Diabetic retinopathy graded by the modified Davis classification.
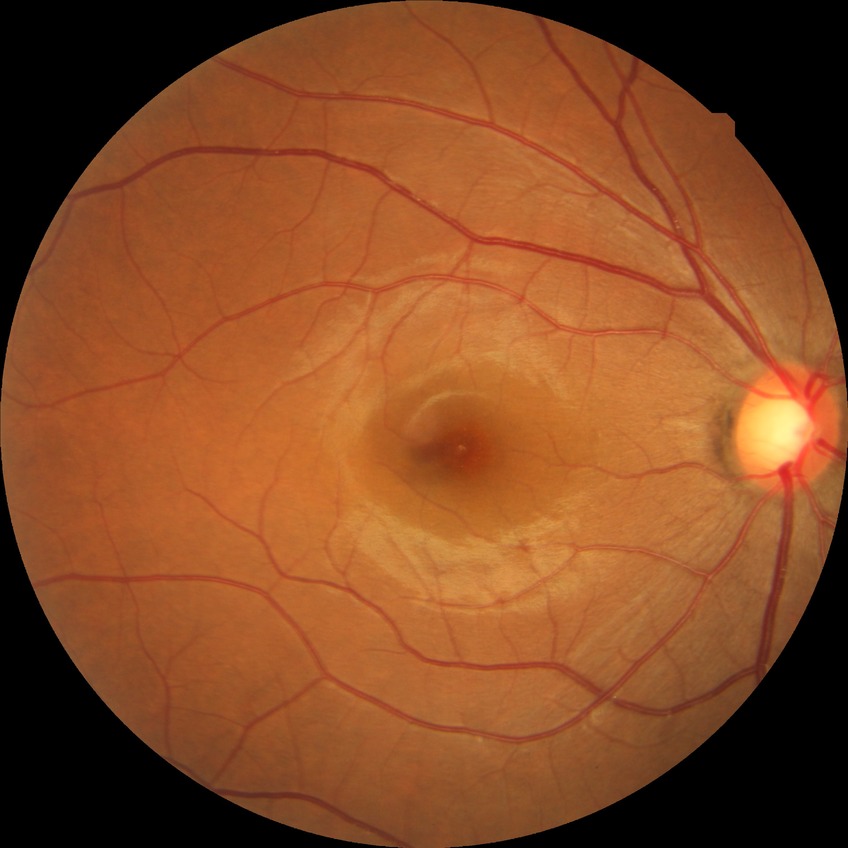 diabetic retinopathy (DR): no diabetic retinopathy (NDR)